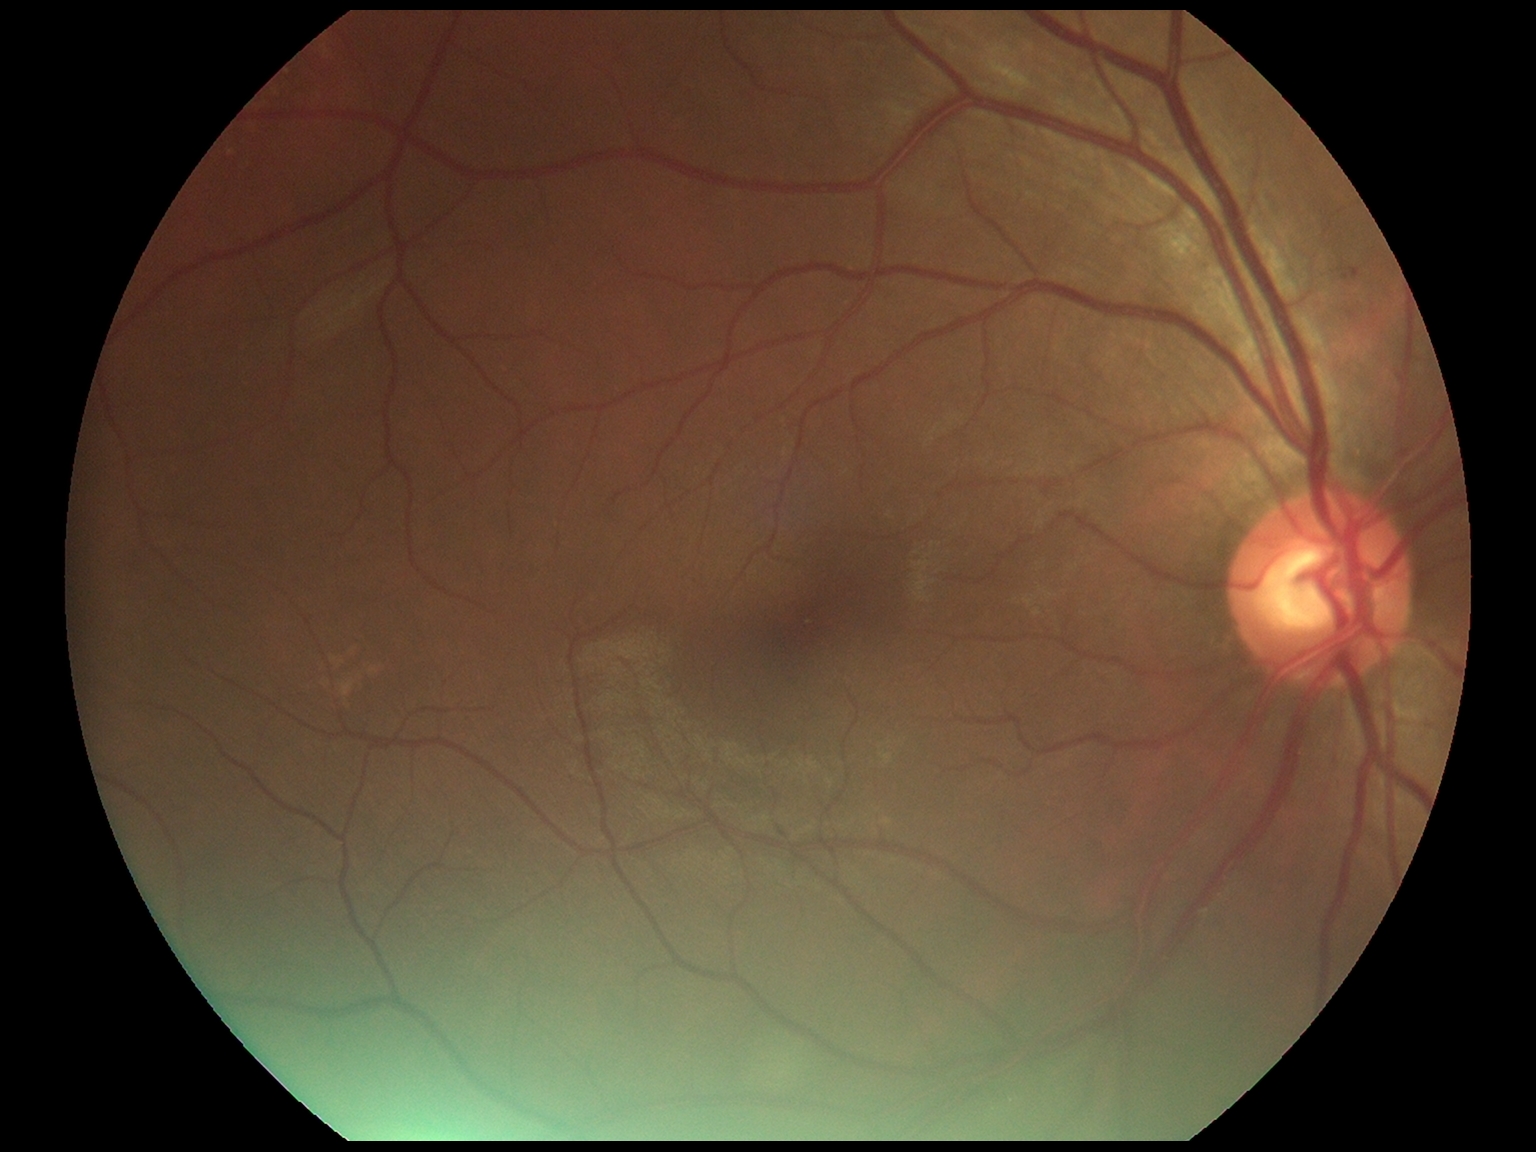
{"dr_grade": "mild NPDR (grade 1)"}